Non-mydriatic acquisition
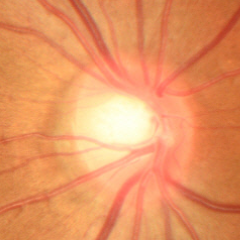 Glaucoma stage = no glaucomatous findings.